2228 x 1652 pixels. Captured after pupil dilation. Fundus photo. Captured on a Topcon TRC-50DX fundus camera. 50-degree field of view. Field includes the optic disc and macula.
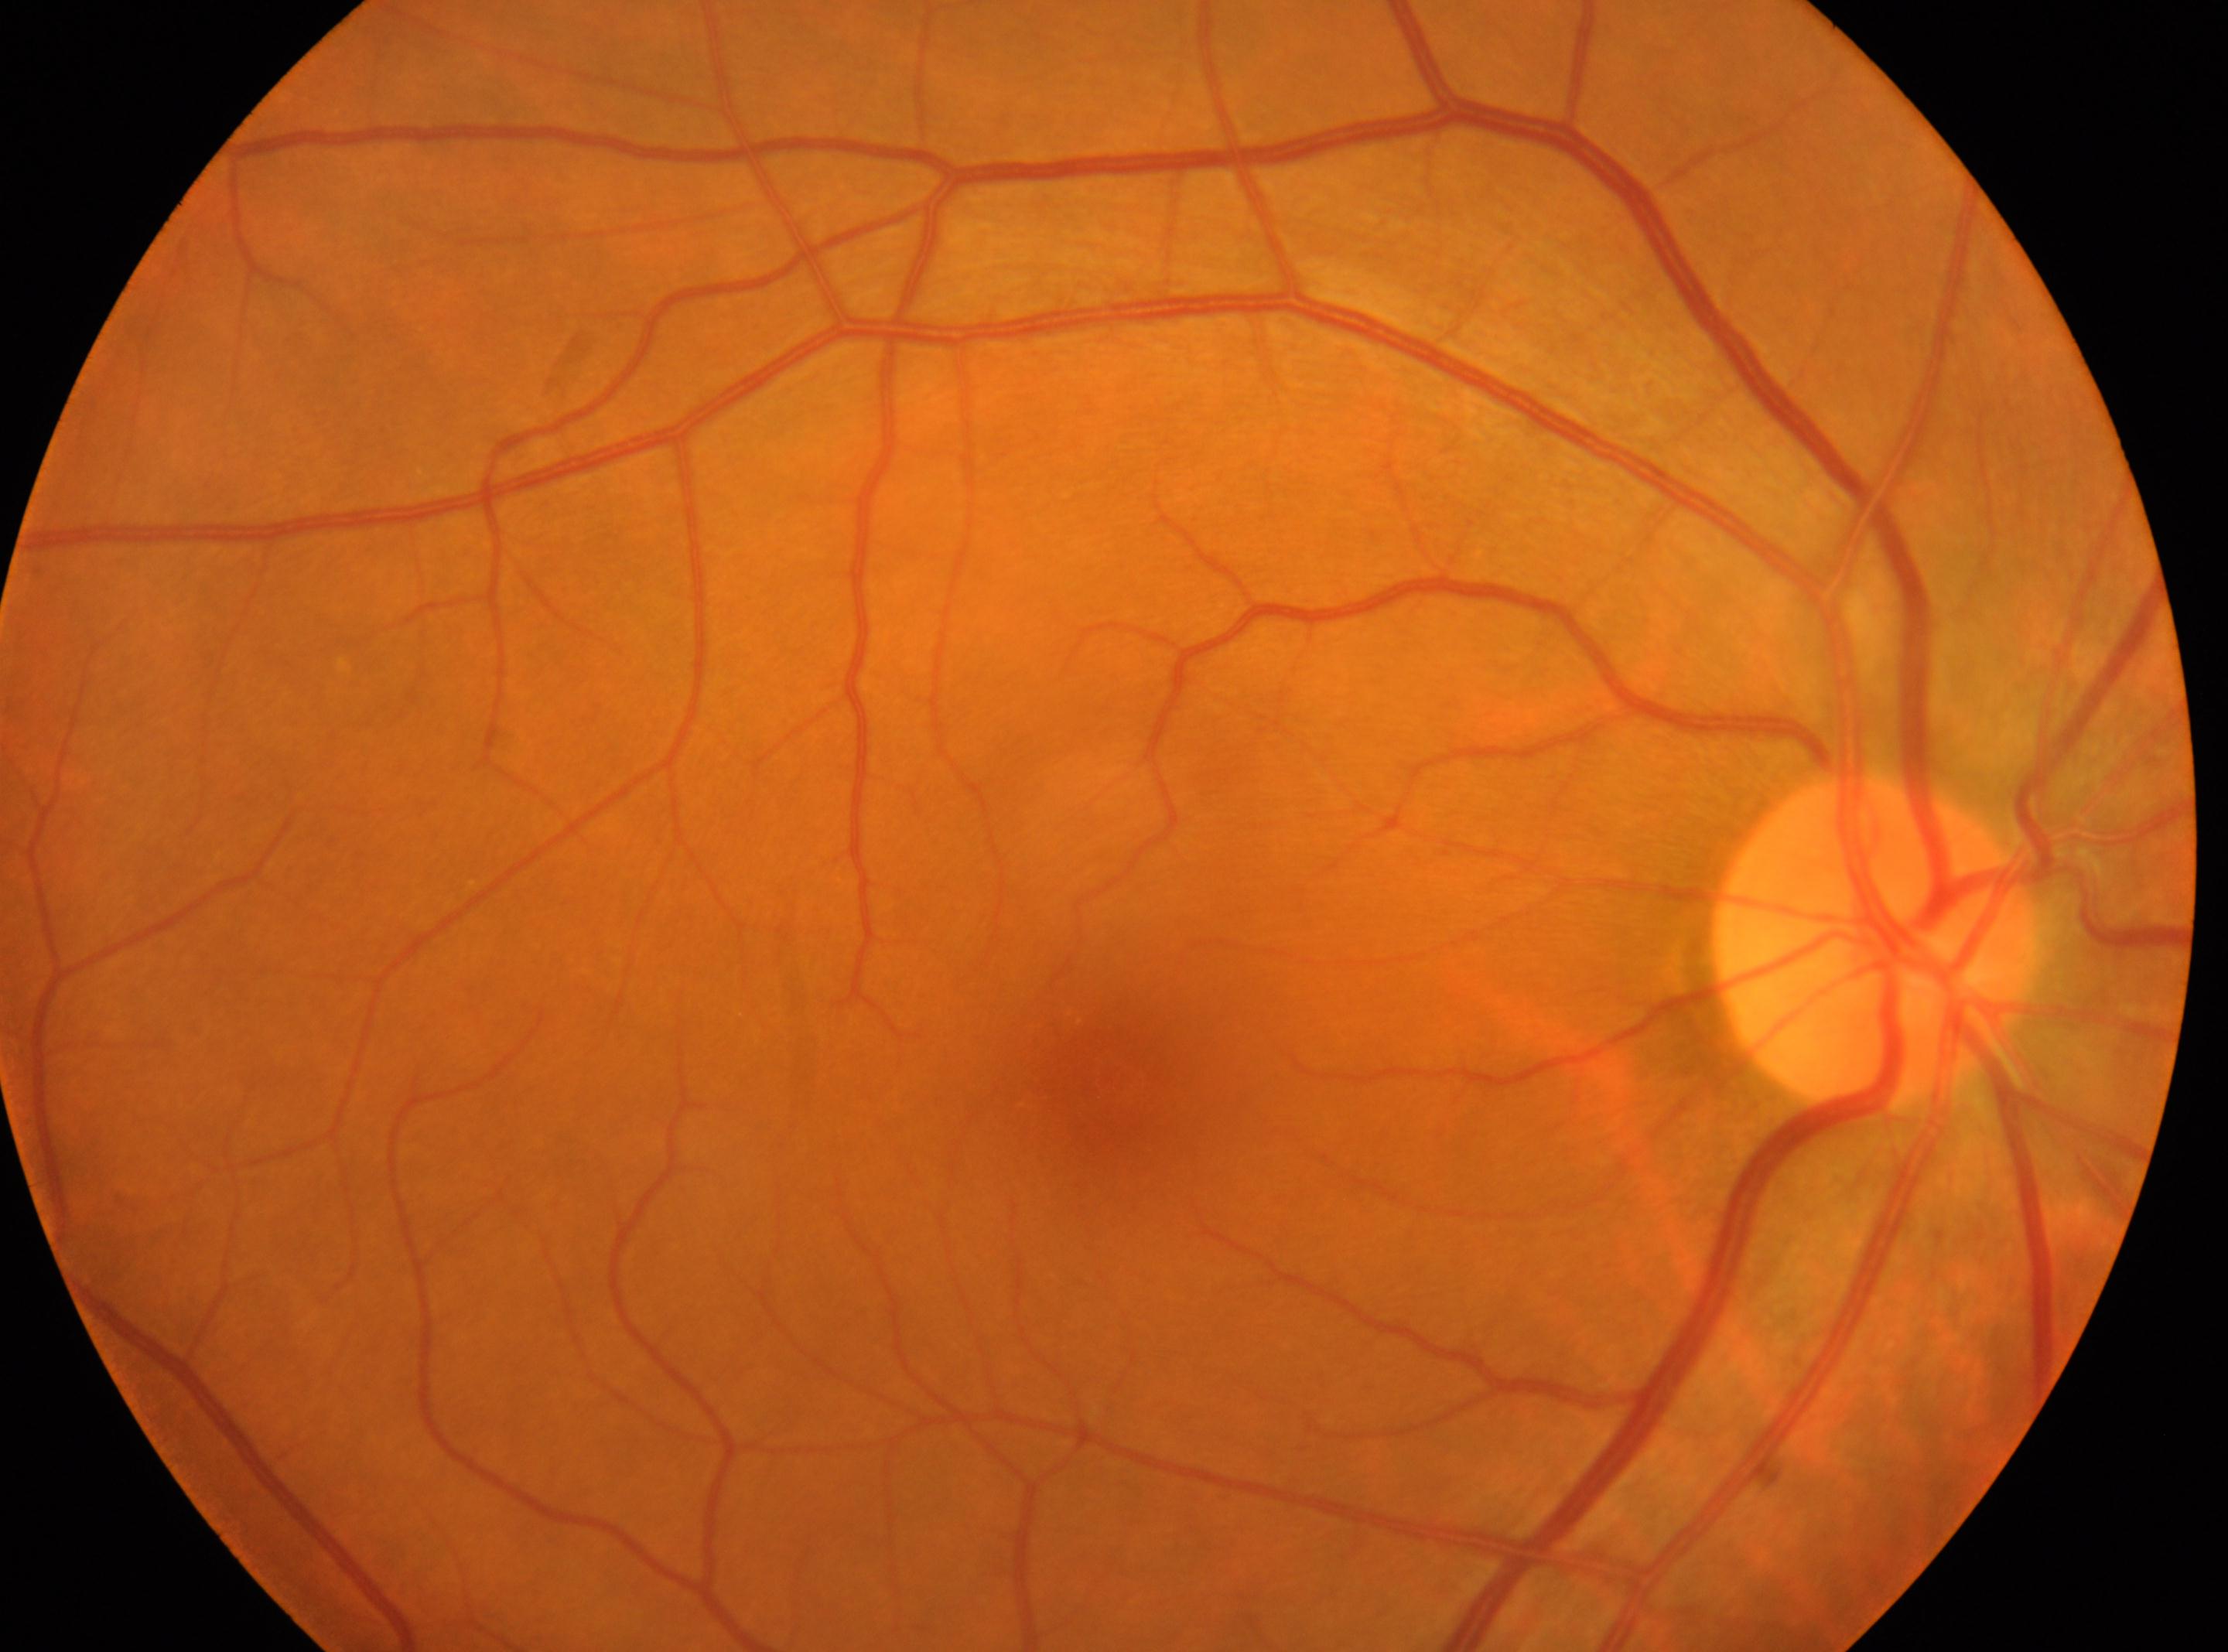 DR is grade 0 (no apparent retinopathy) — no visible signs of diabetic retinopathy.
The image shows the right eye.
The optic disc center is at (1877, 942).
Fovea centralis: (1114, 1078).